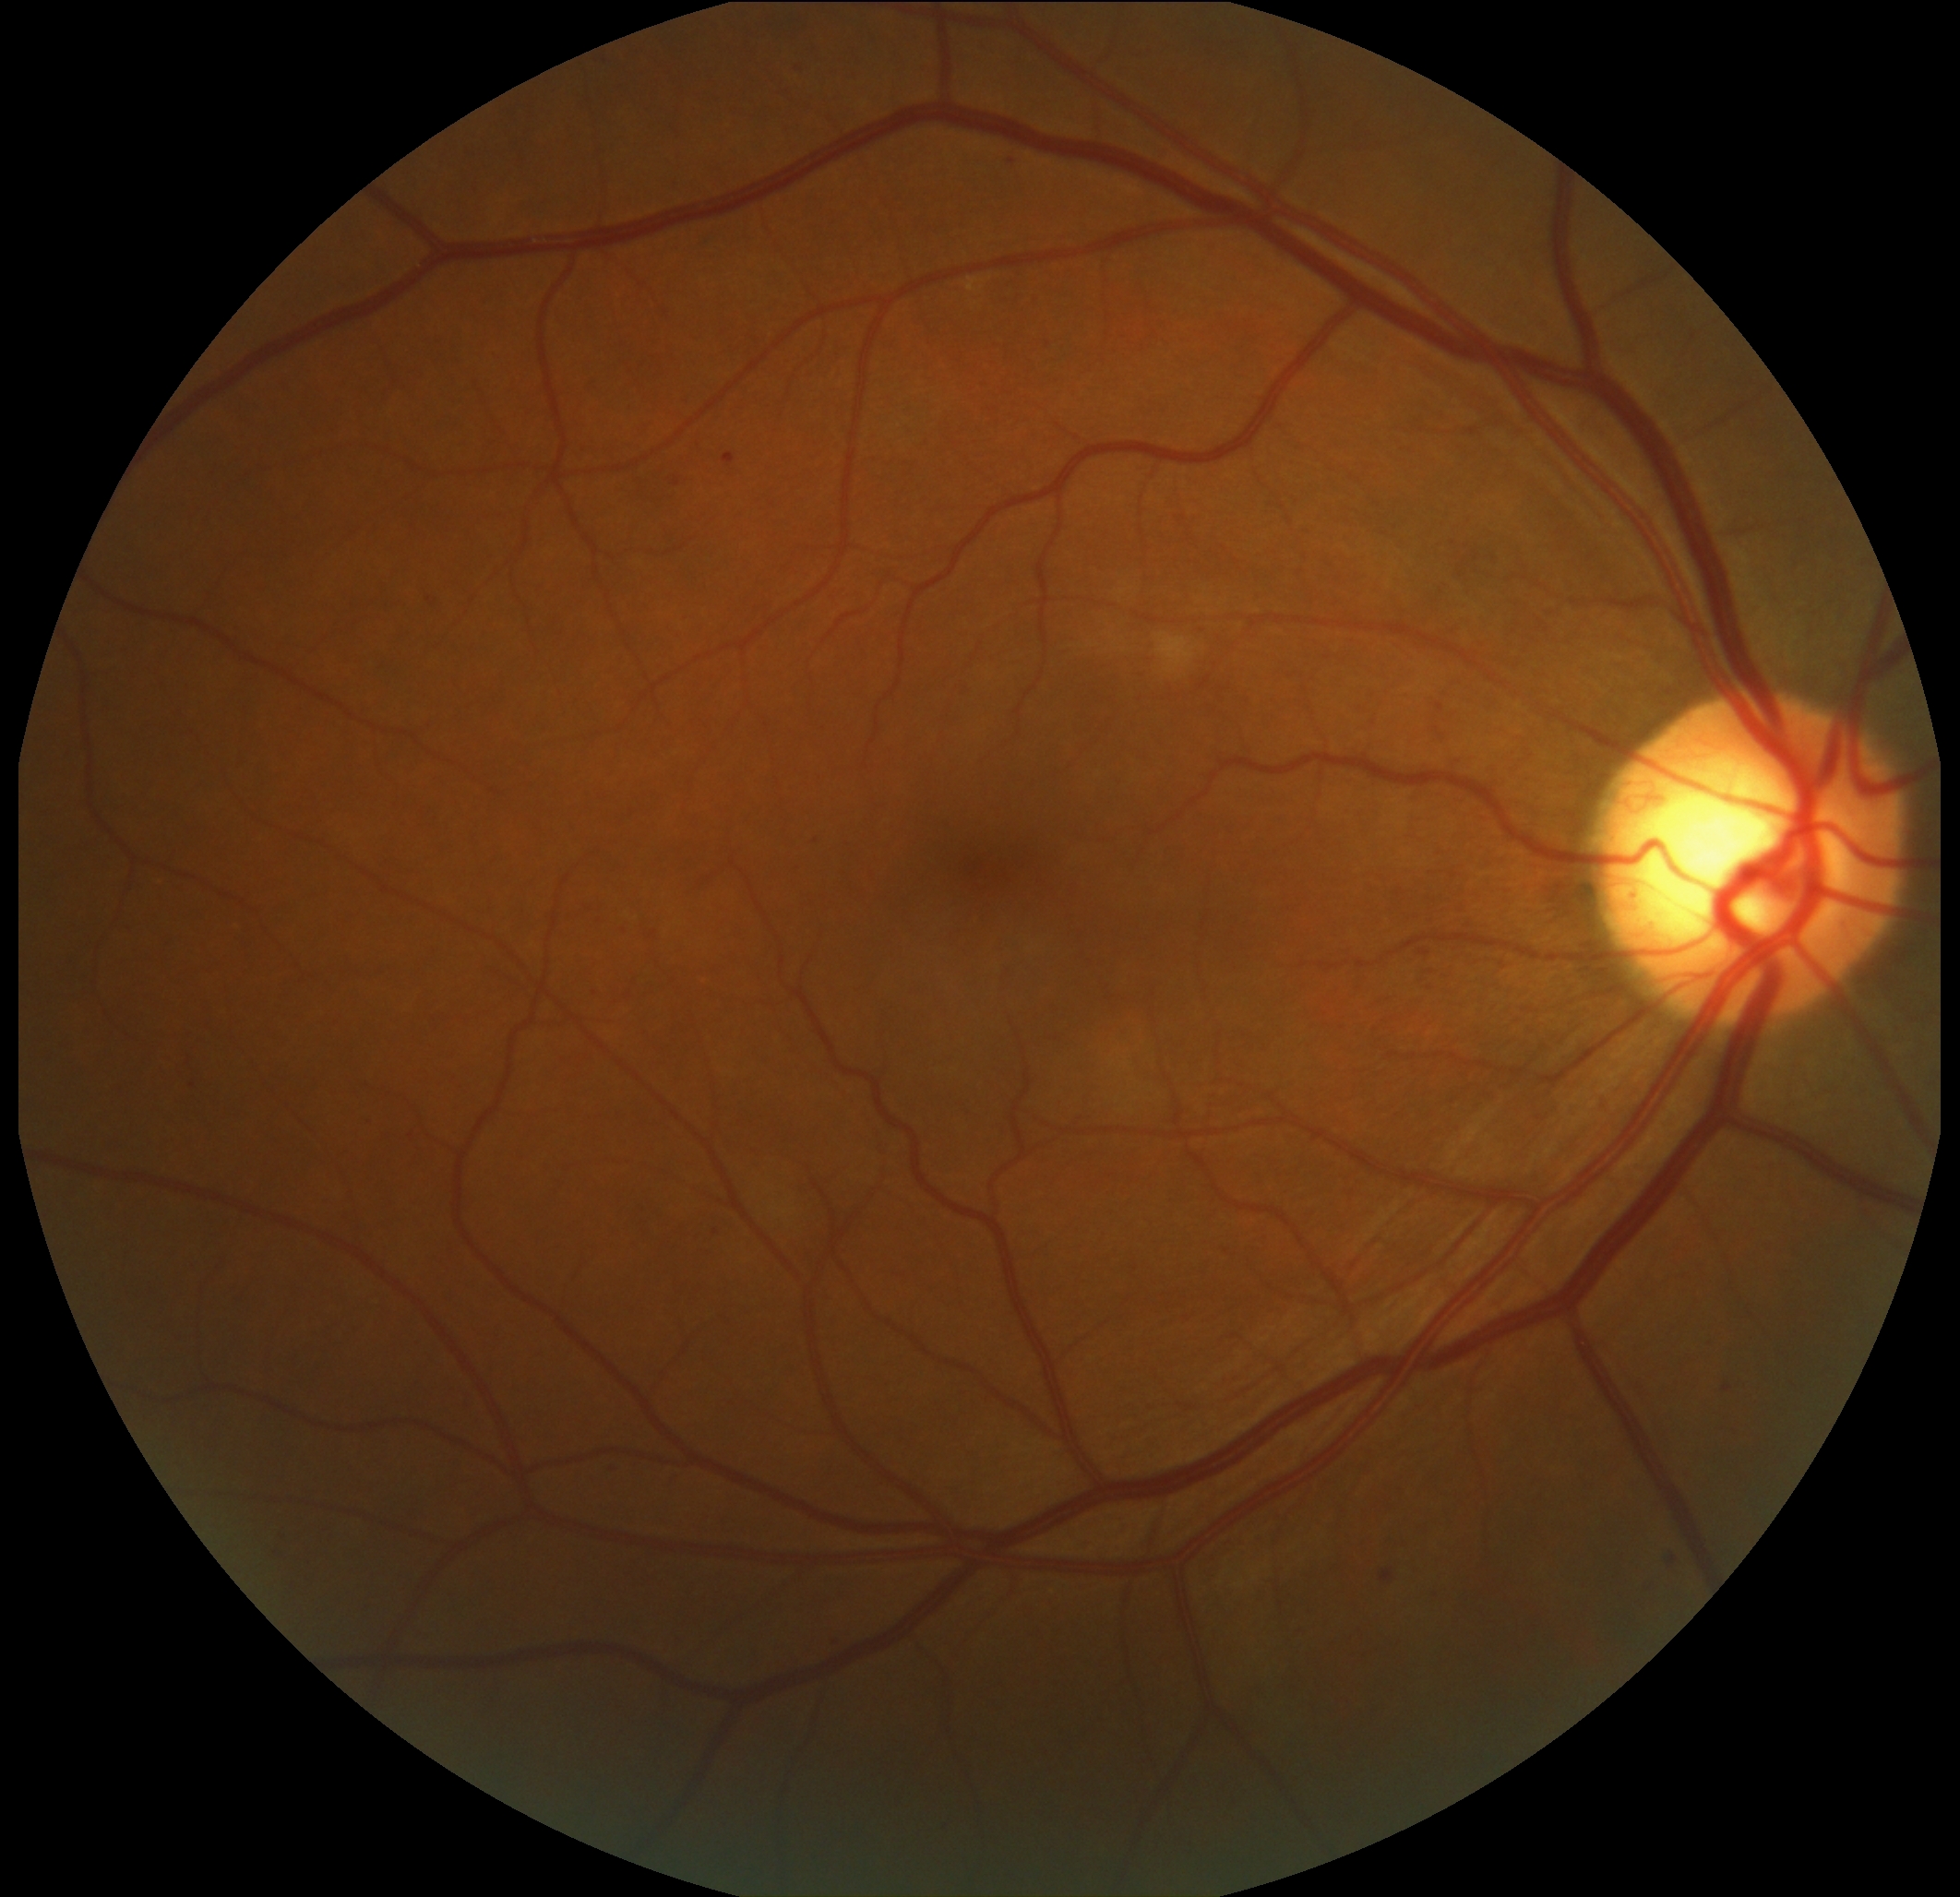

DR: moderate NPDR (grade 2).